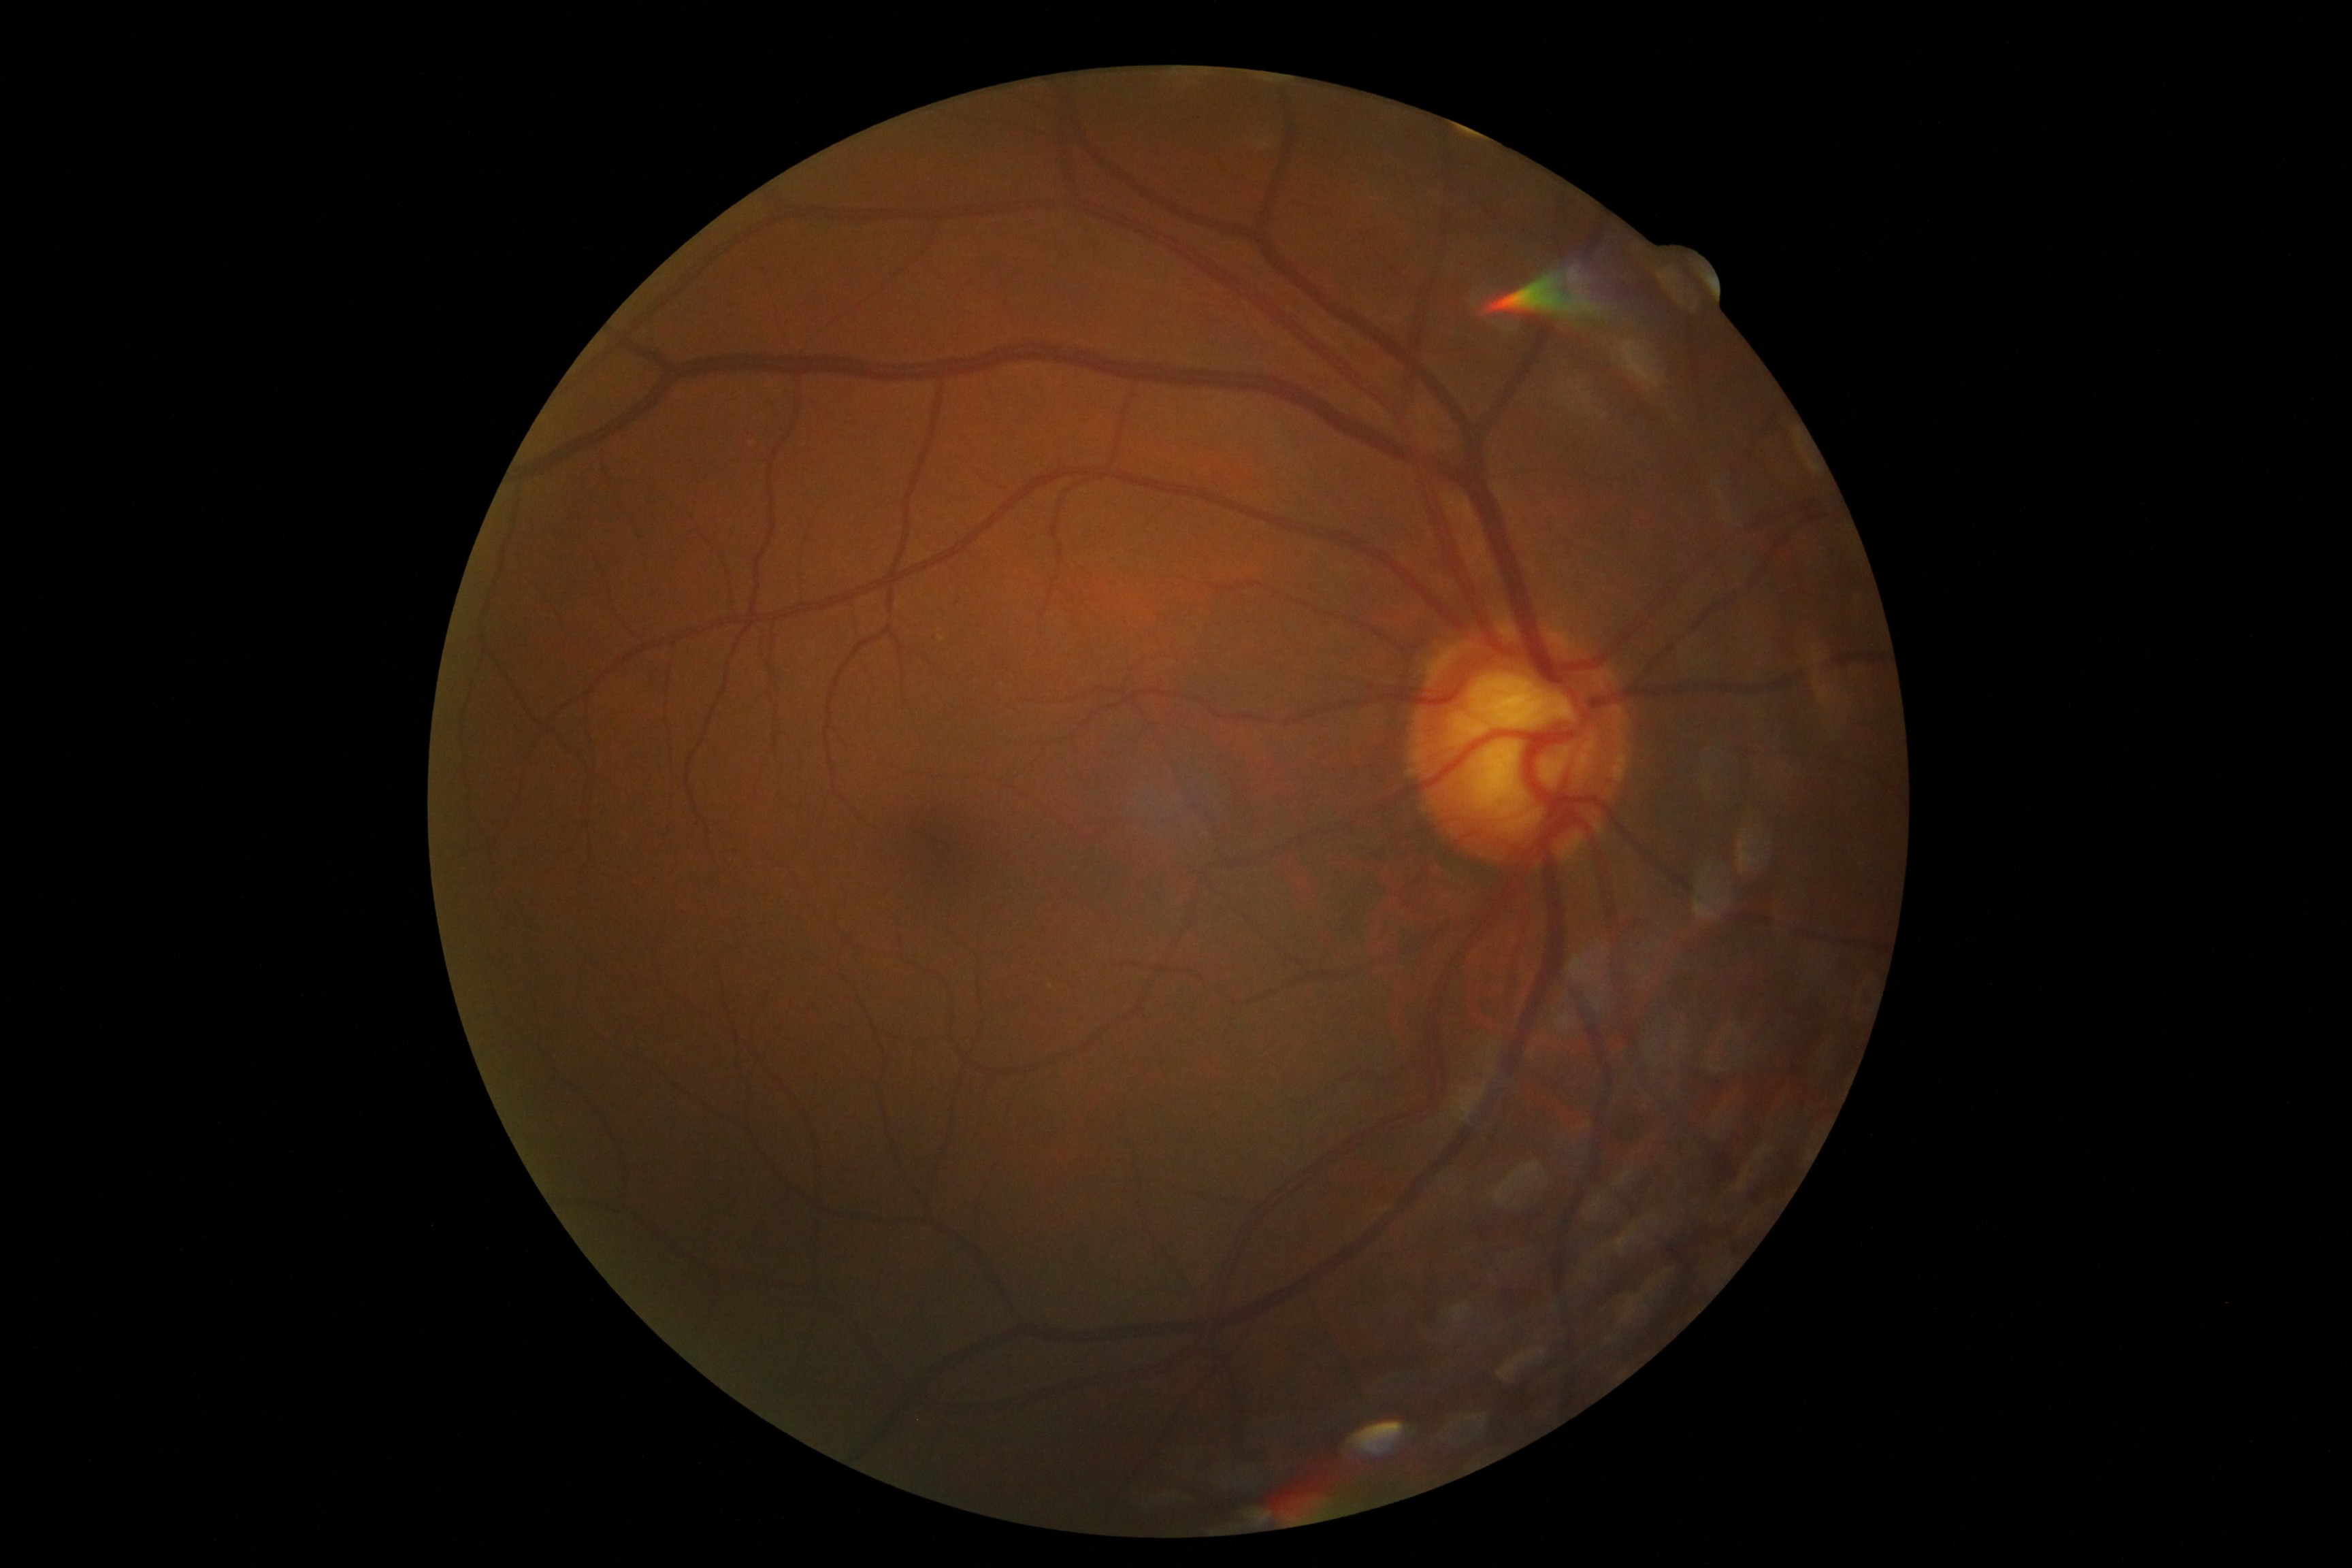

Retinopathy grade: 0.